640 by 480 pixels · pediatric retinal photograph (wide-field) · 130° field of view (Clarity RetCam 3) — 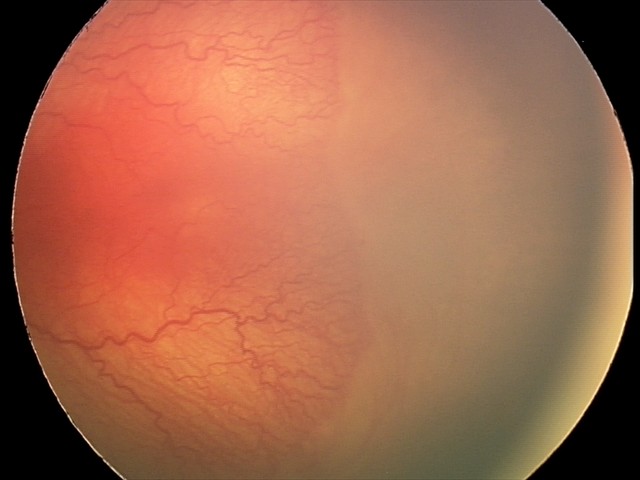 Screening diagnosis: aggressive retinopathy of prematurity | plus disease.